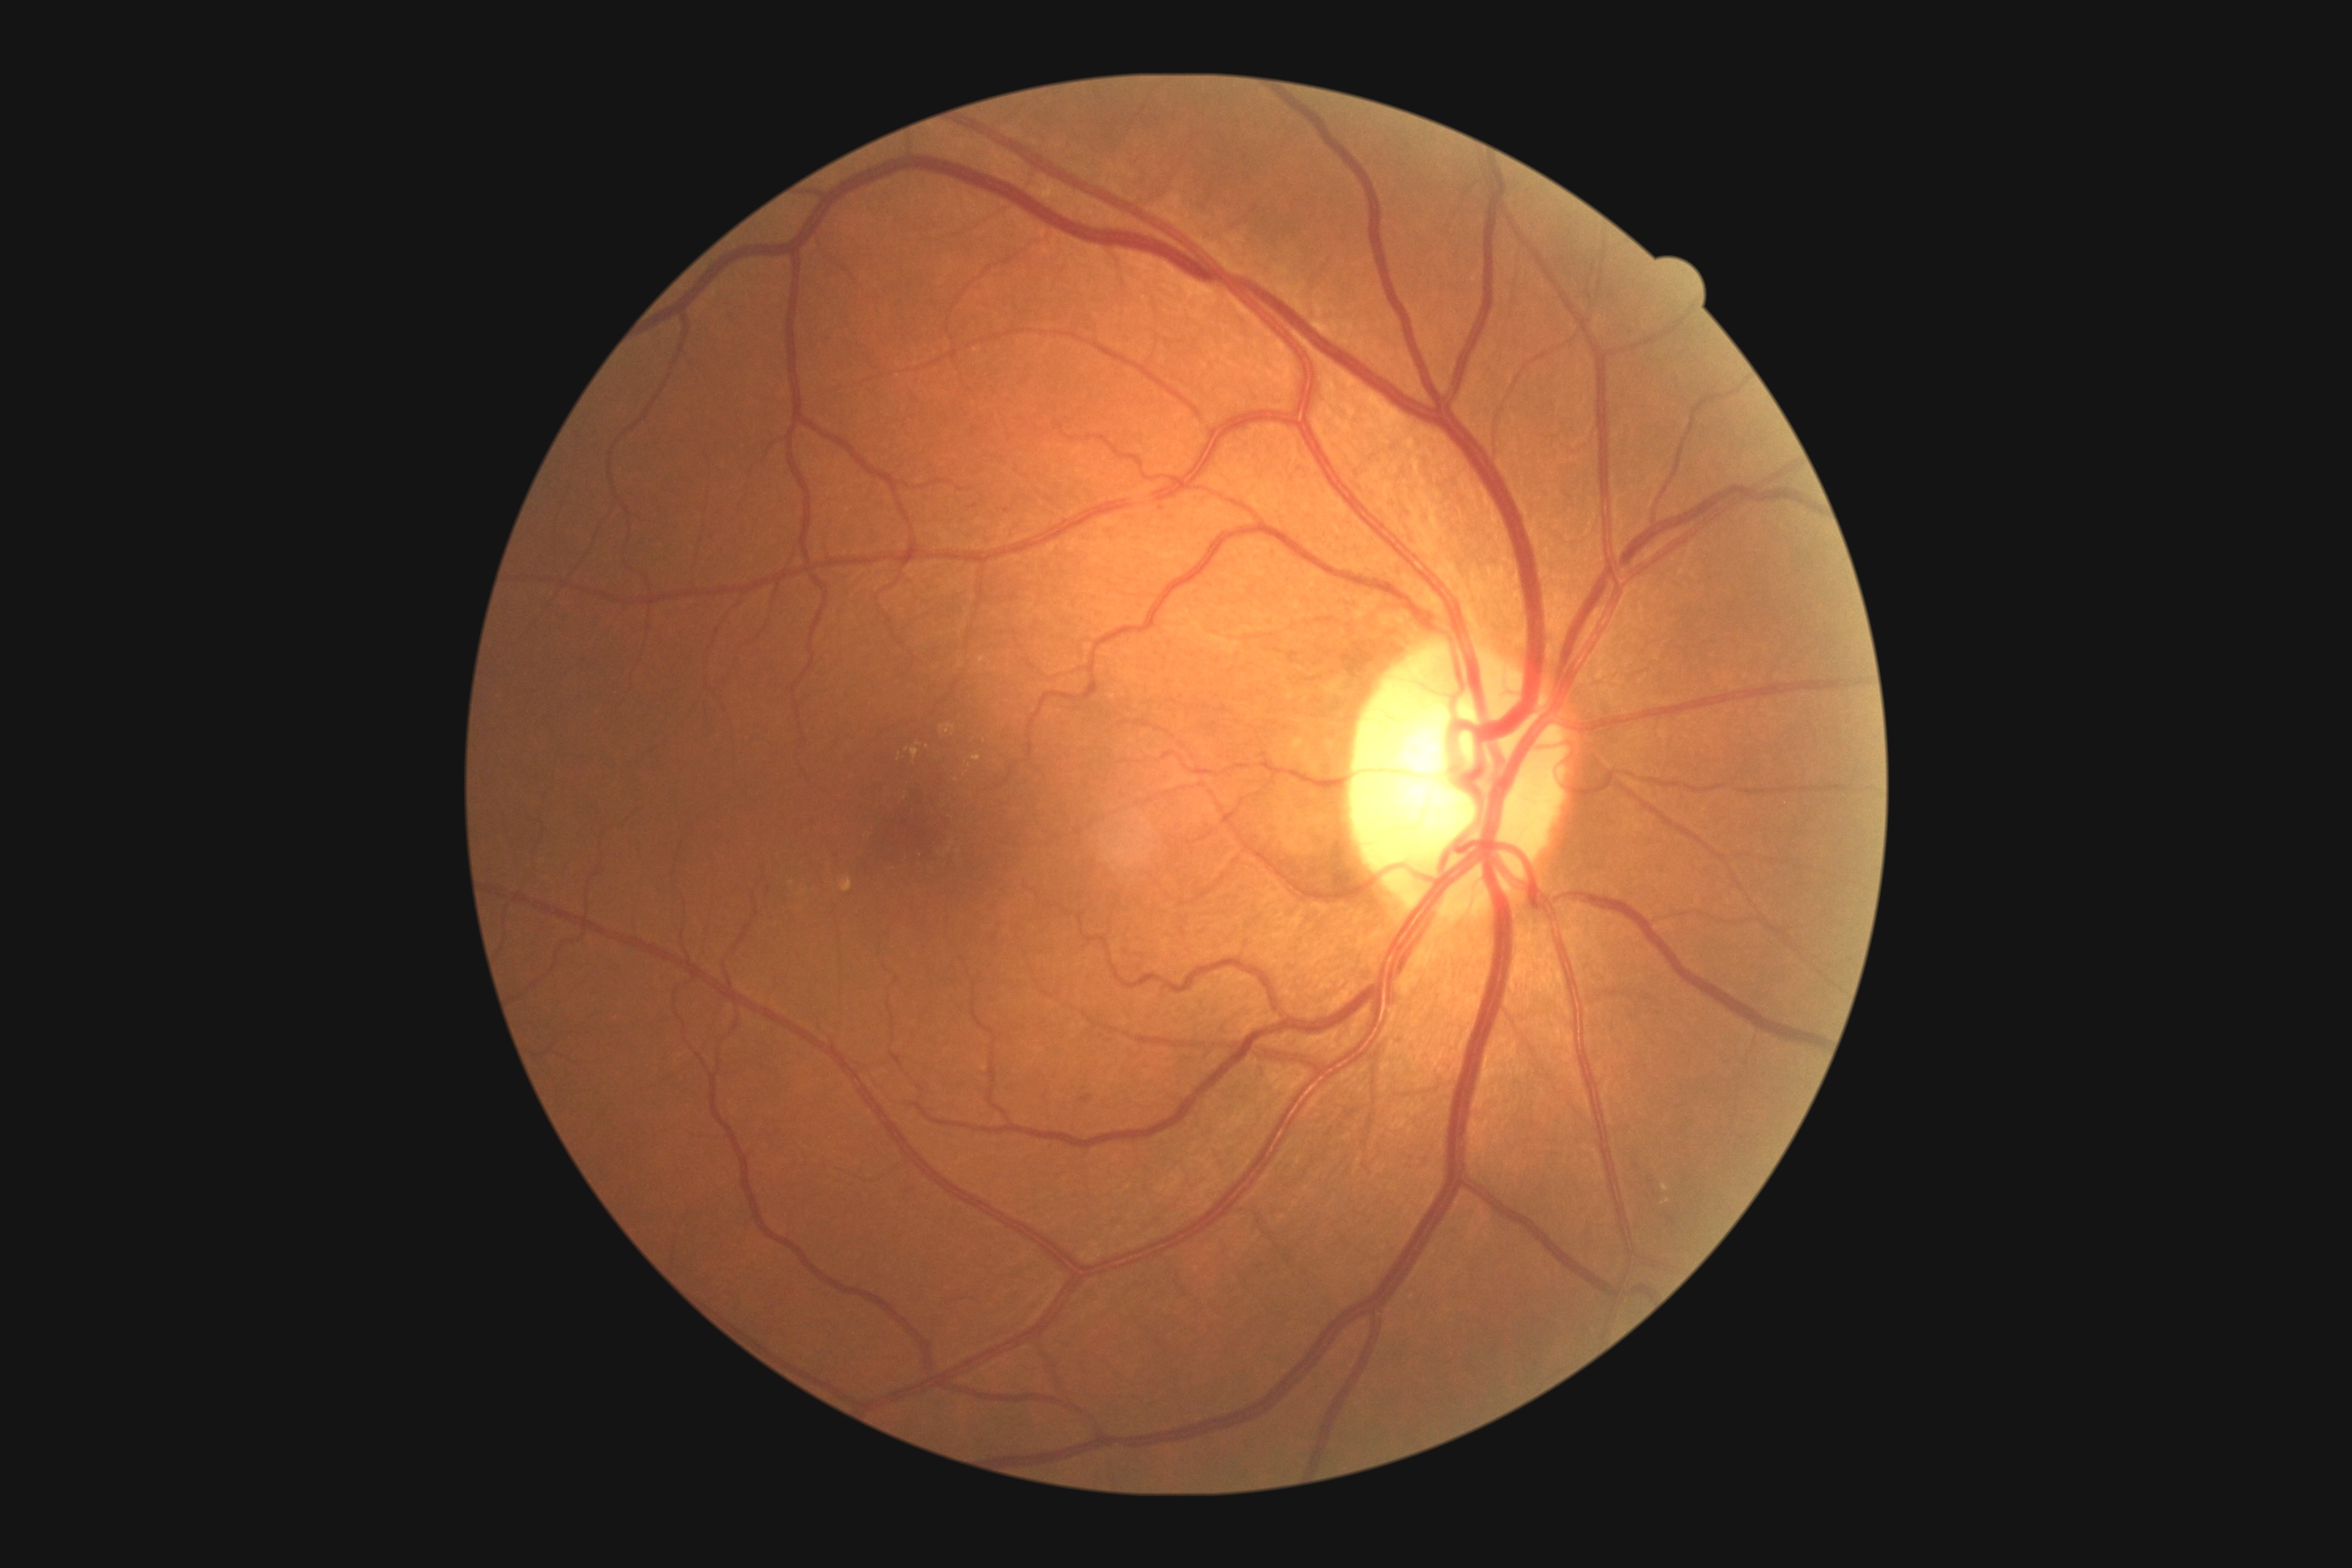

diabetic retinopathy (DR): grade 2 (moderate NPDR).